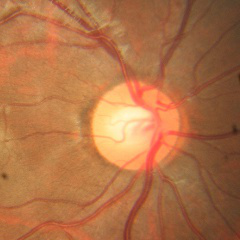 There is evidence of no evidence of glaucoma.